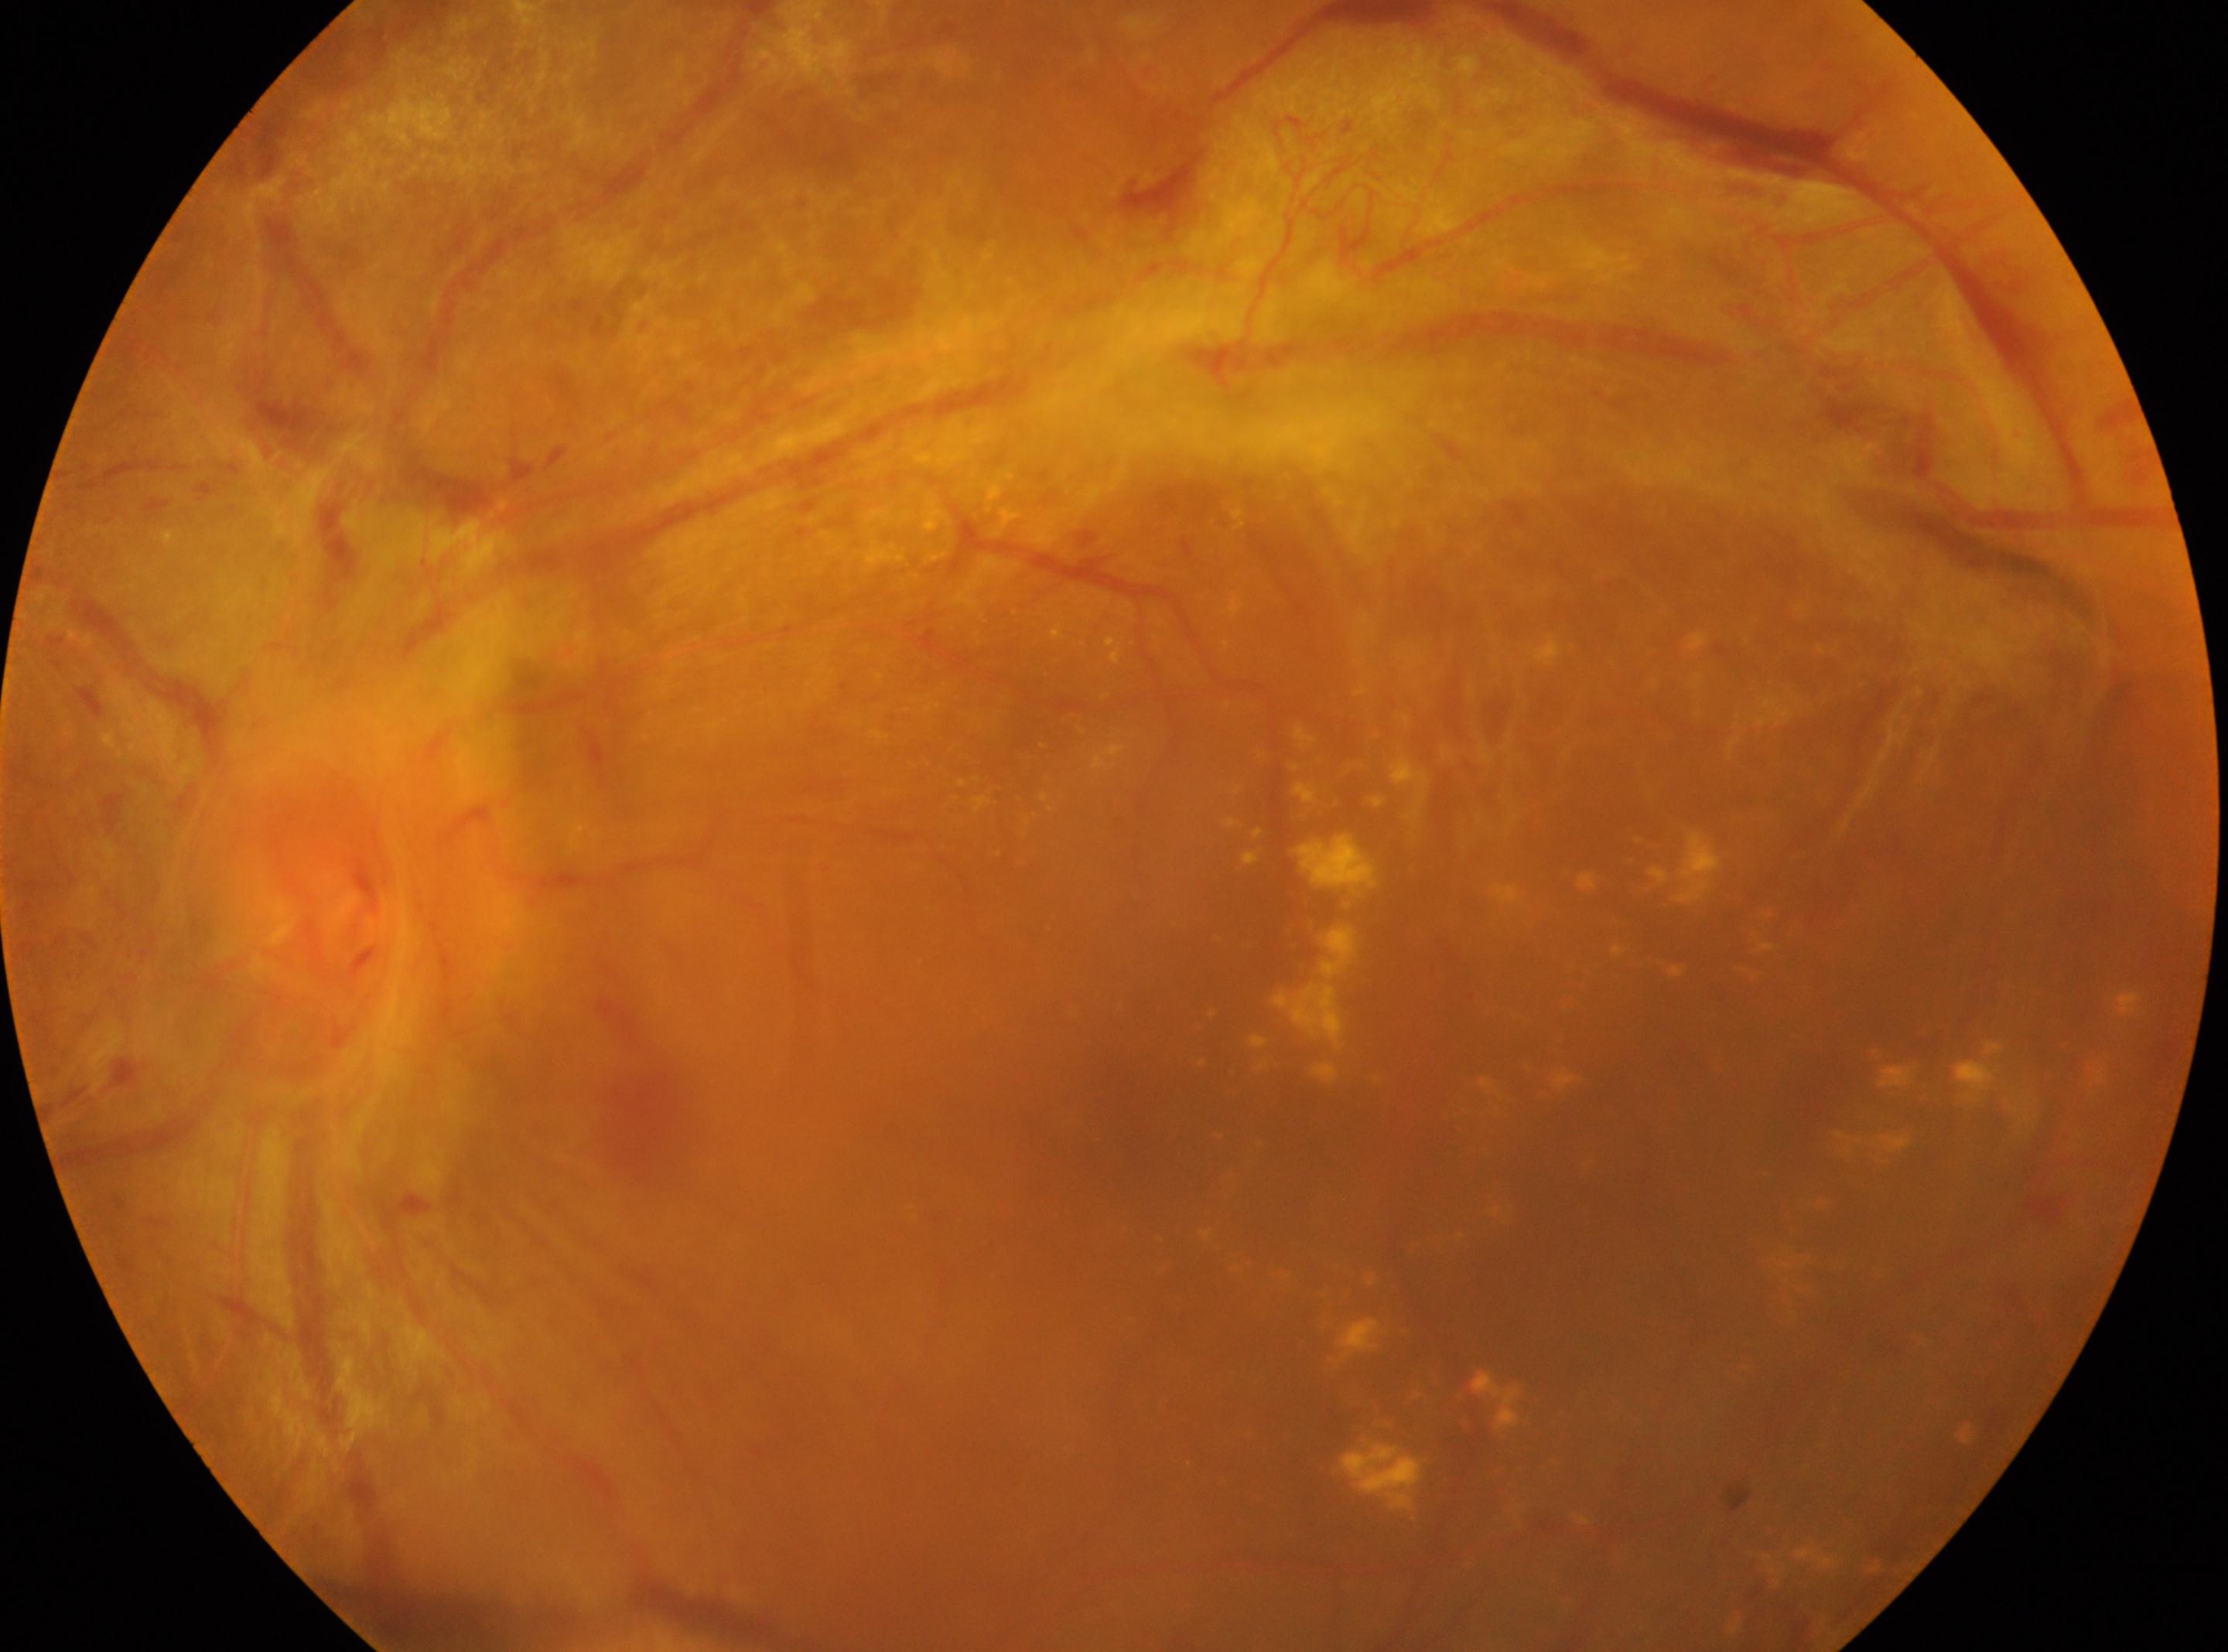
Findings:
– ONH: 362, 869
– laterality: left eye
– fovea: 1139, 1118
– DR: 4